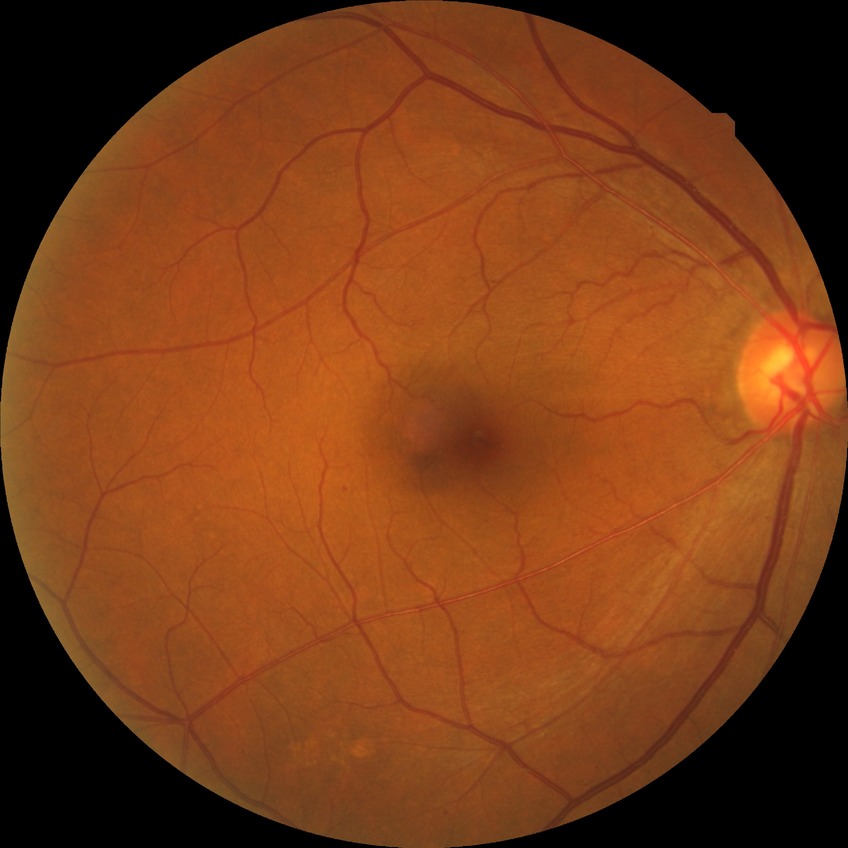

Retinopathy grade is no diabetic retinopathy.